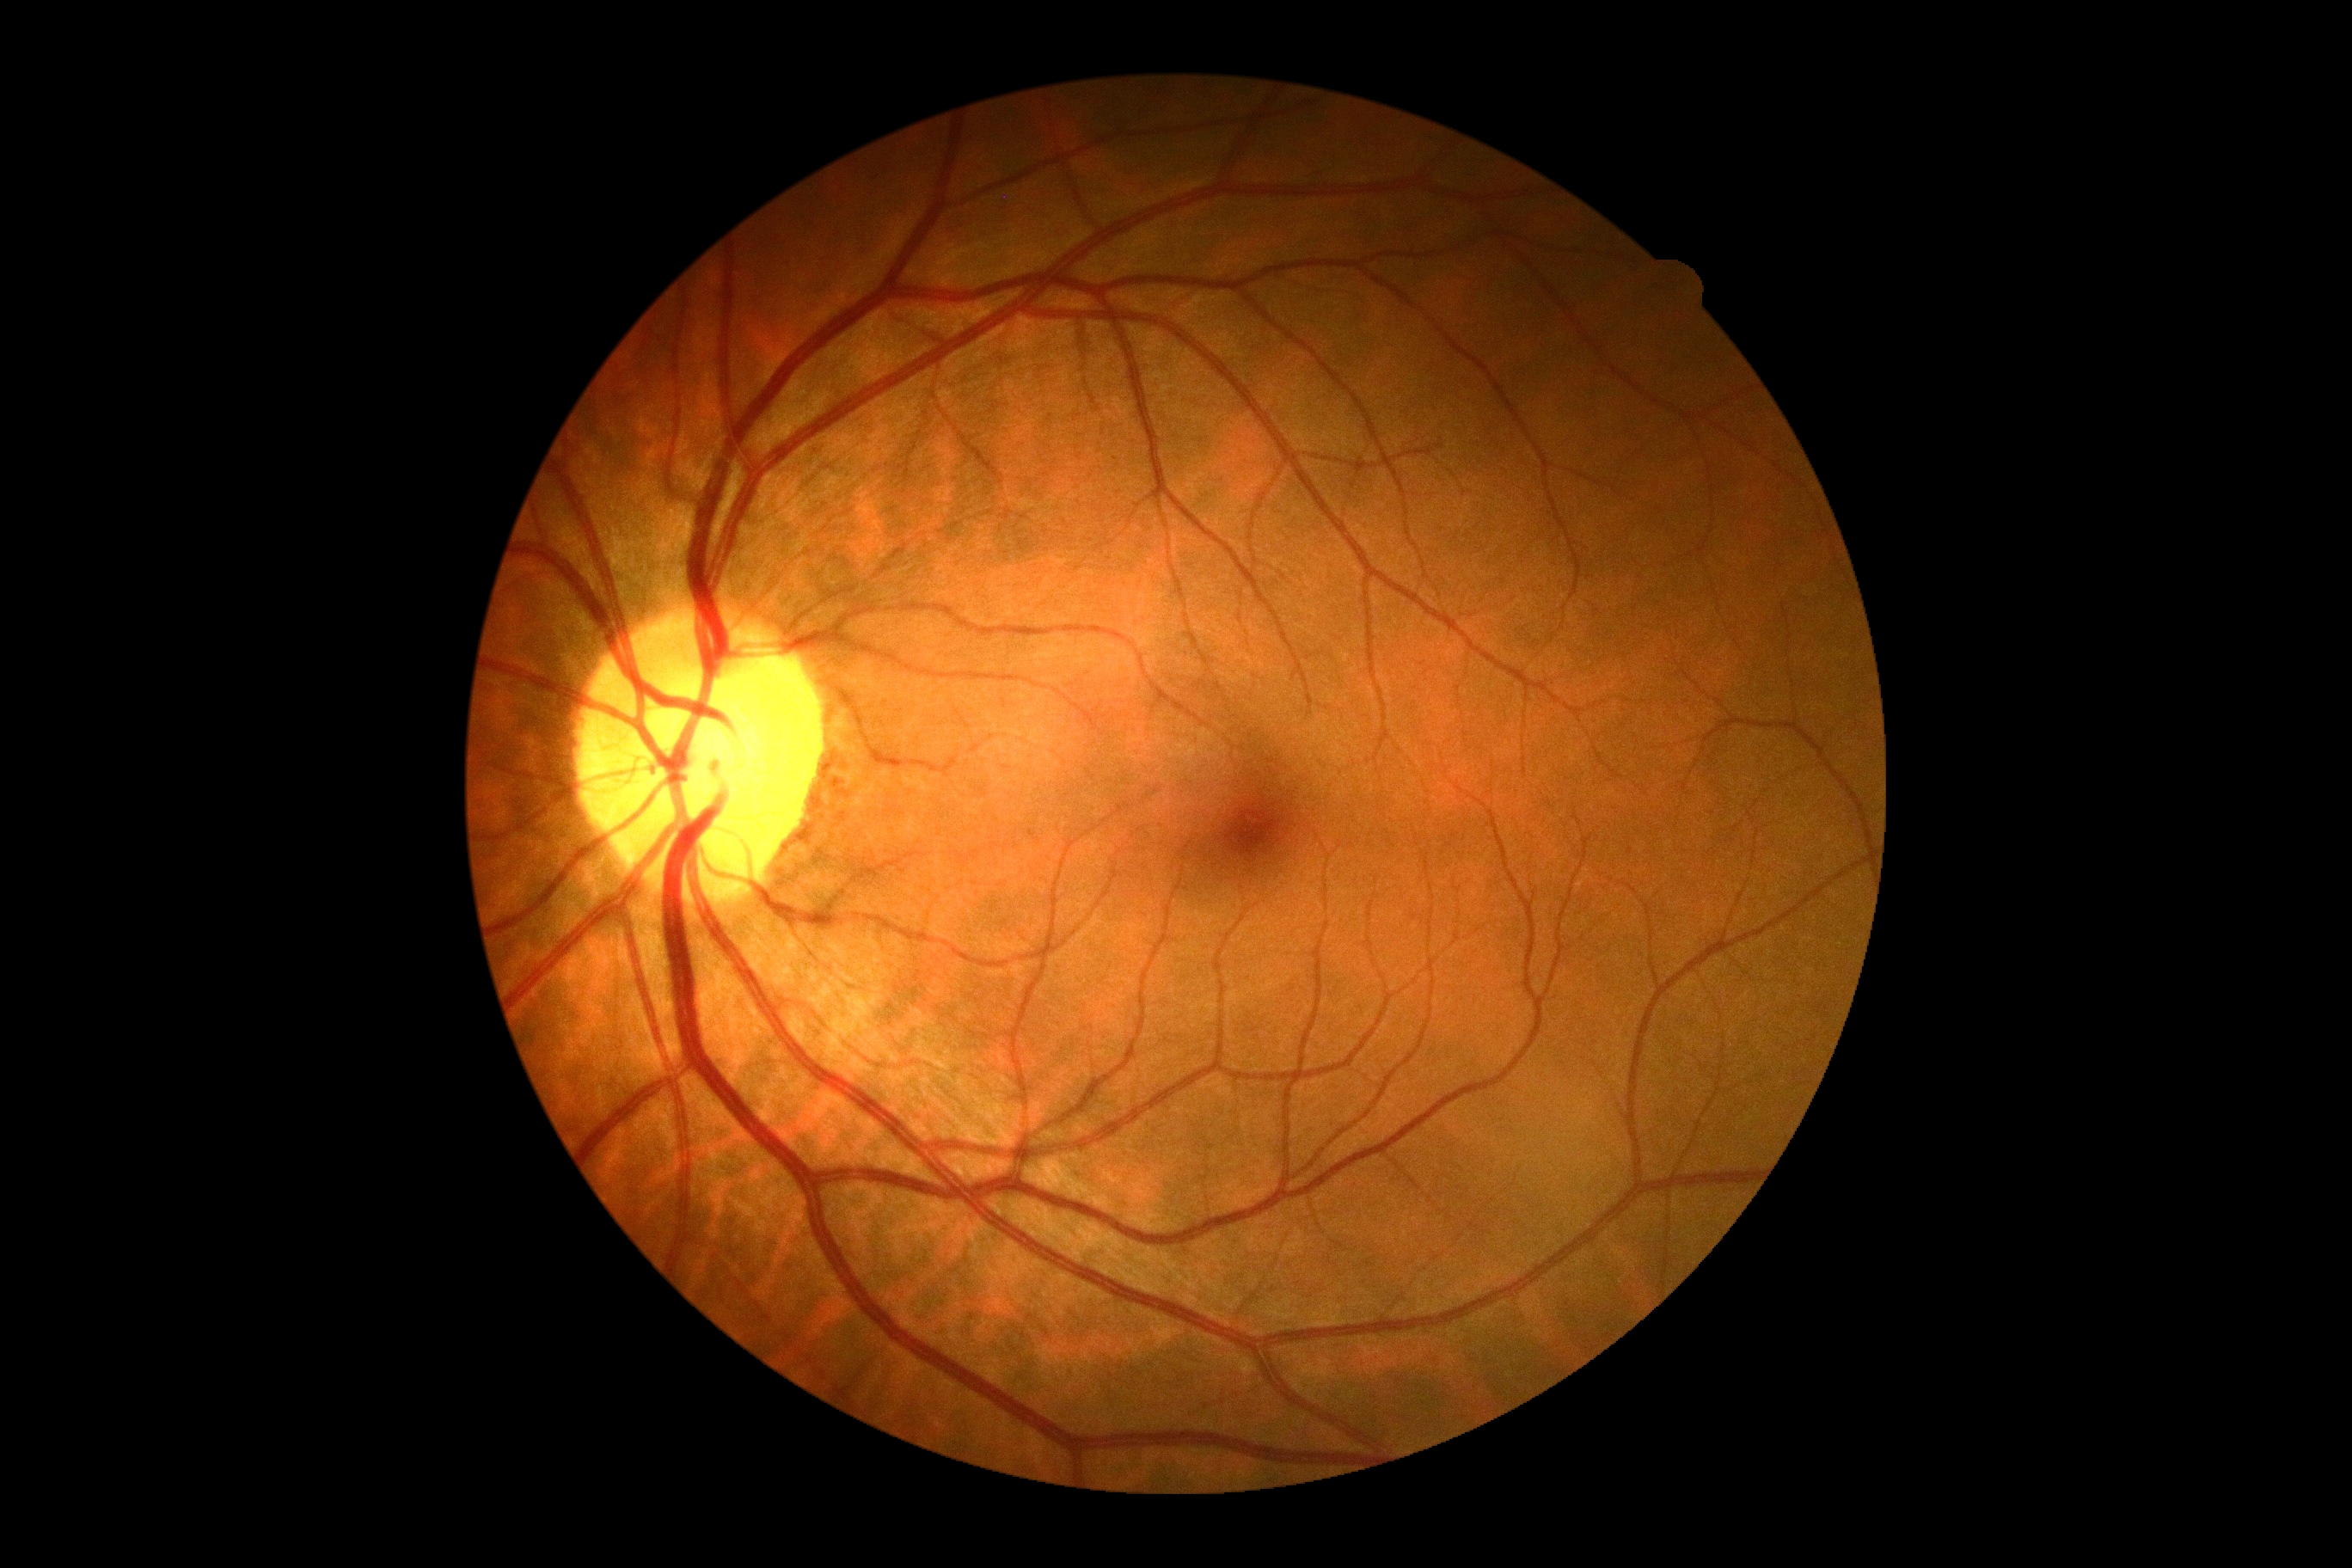
Retinopathy grade is 0. No signs of diabetic retinopathy.